2352 by 1568 pixels.
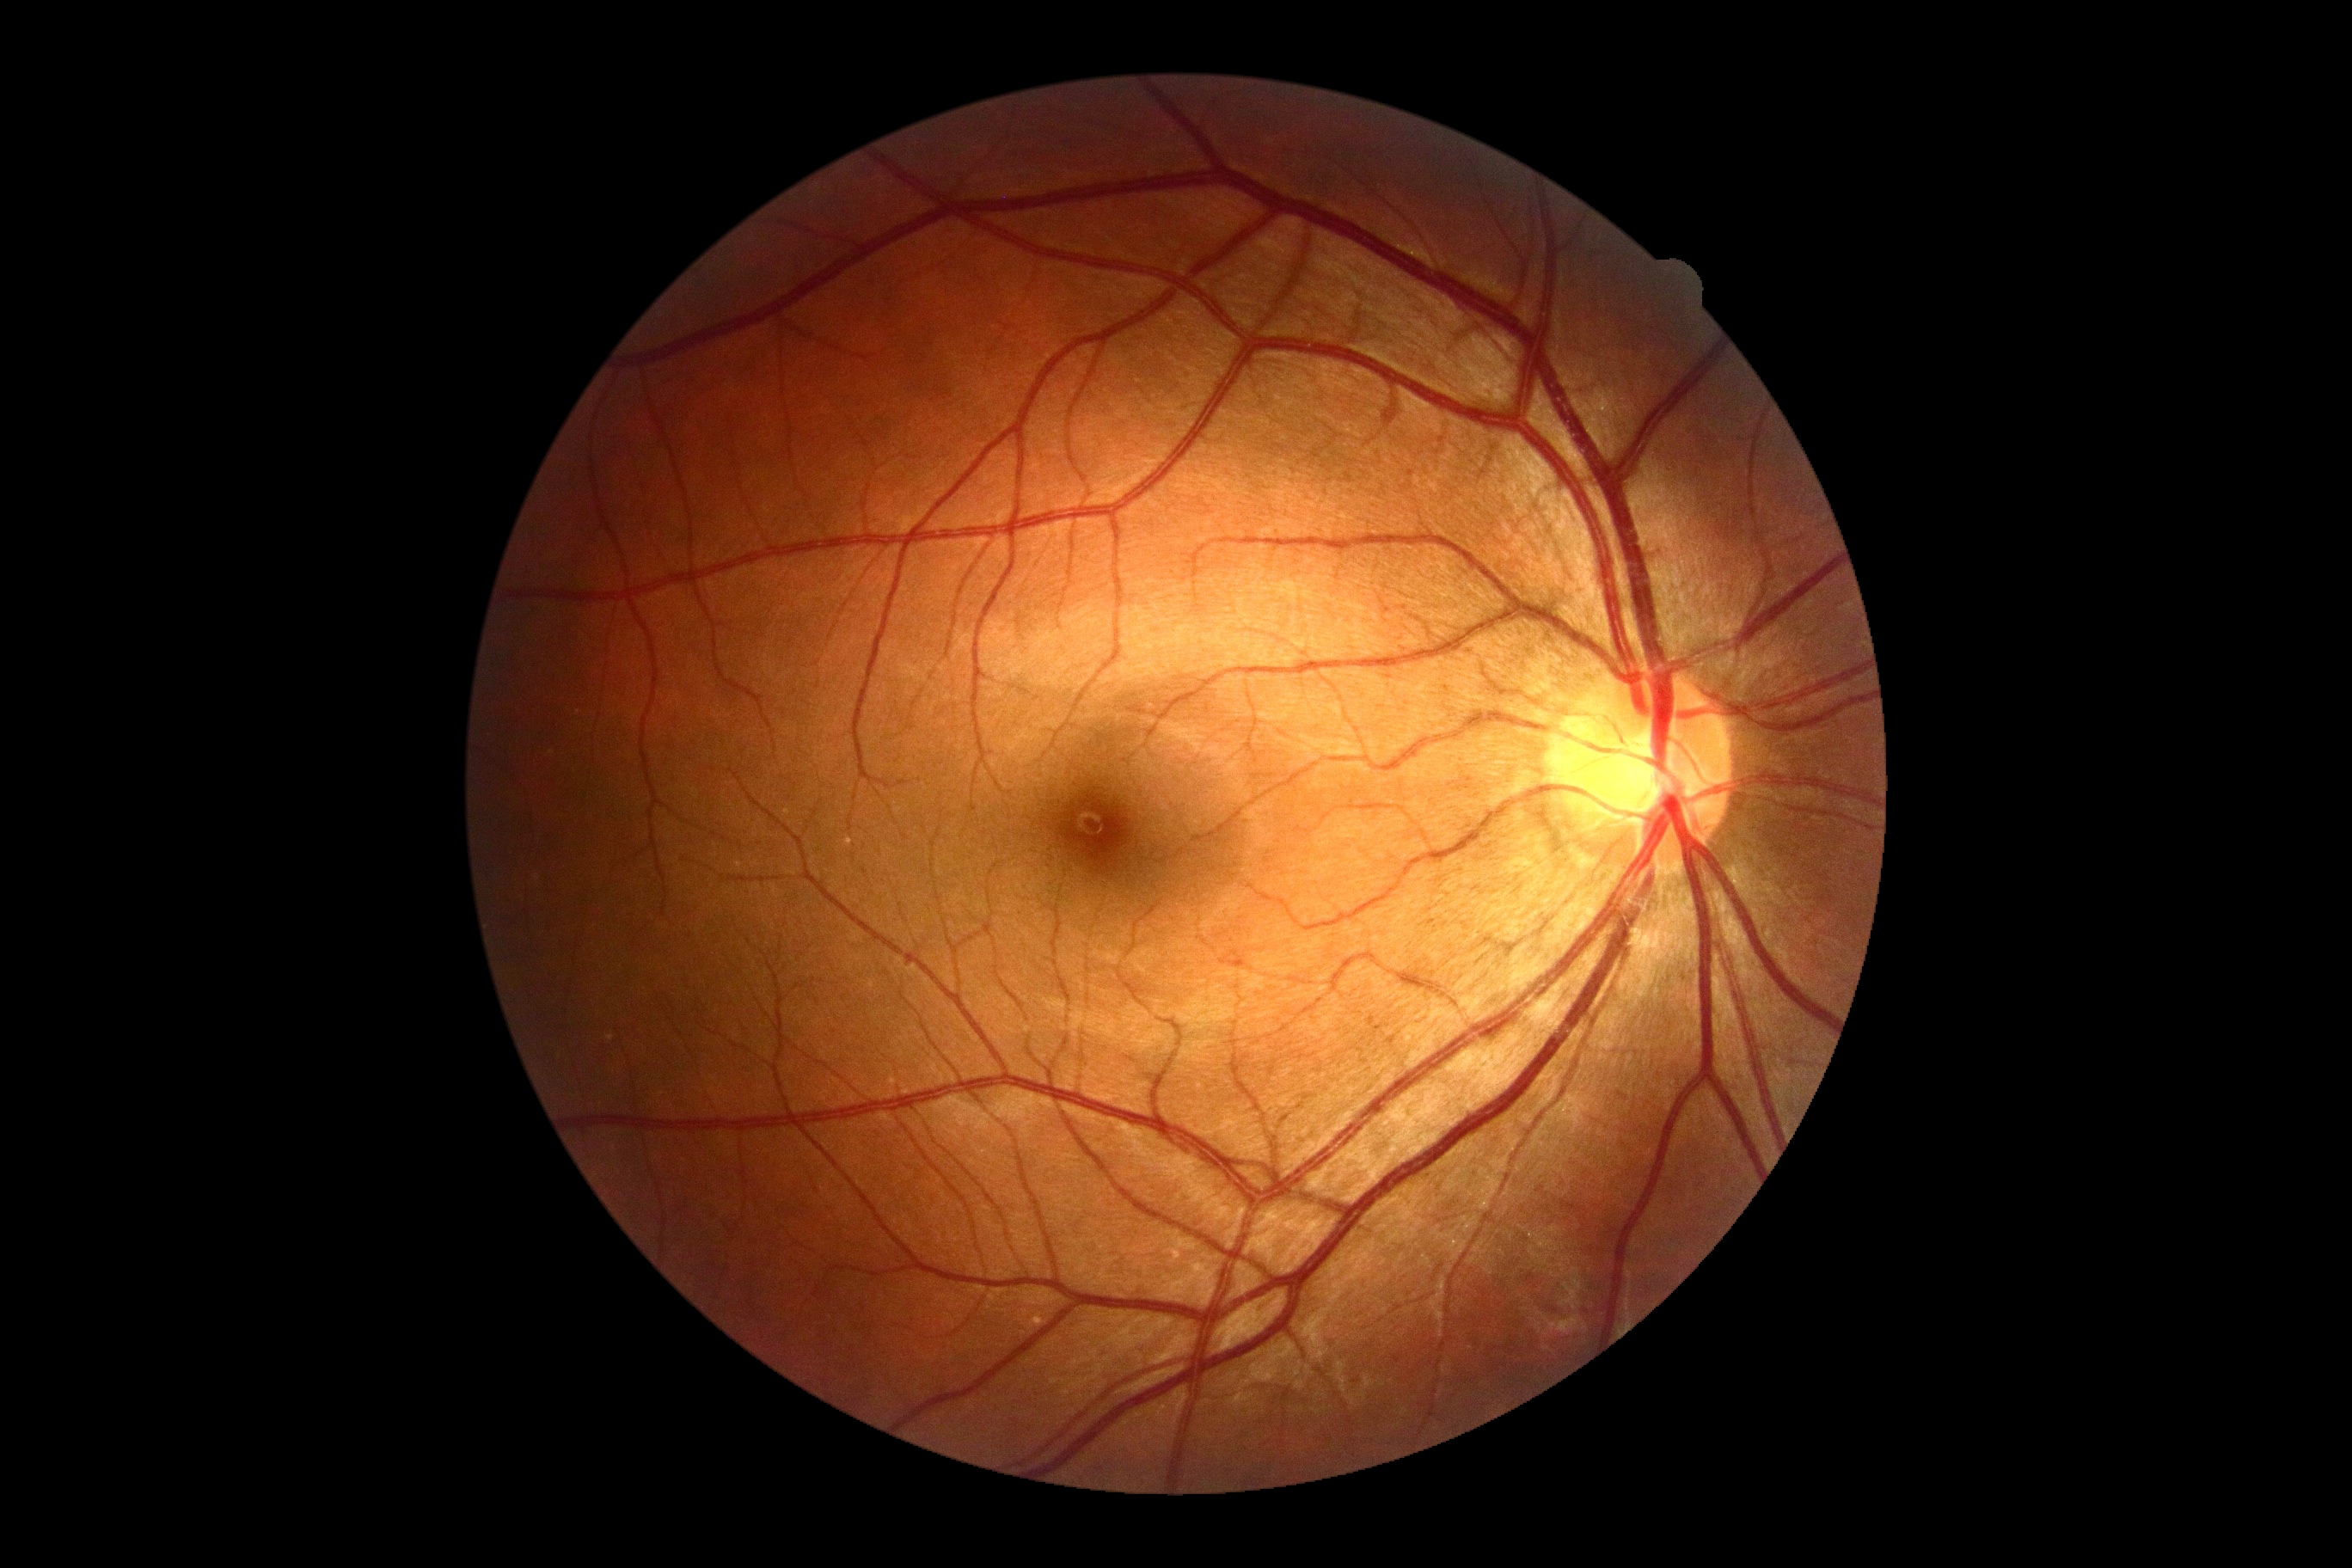

dr_grade: grade 0